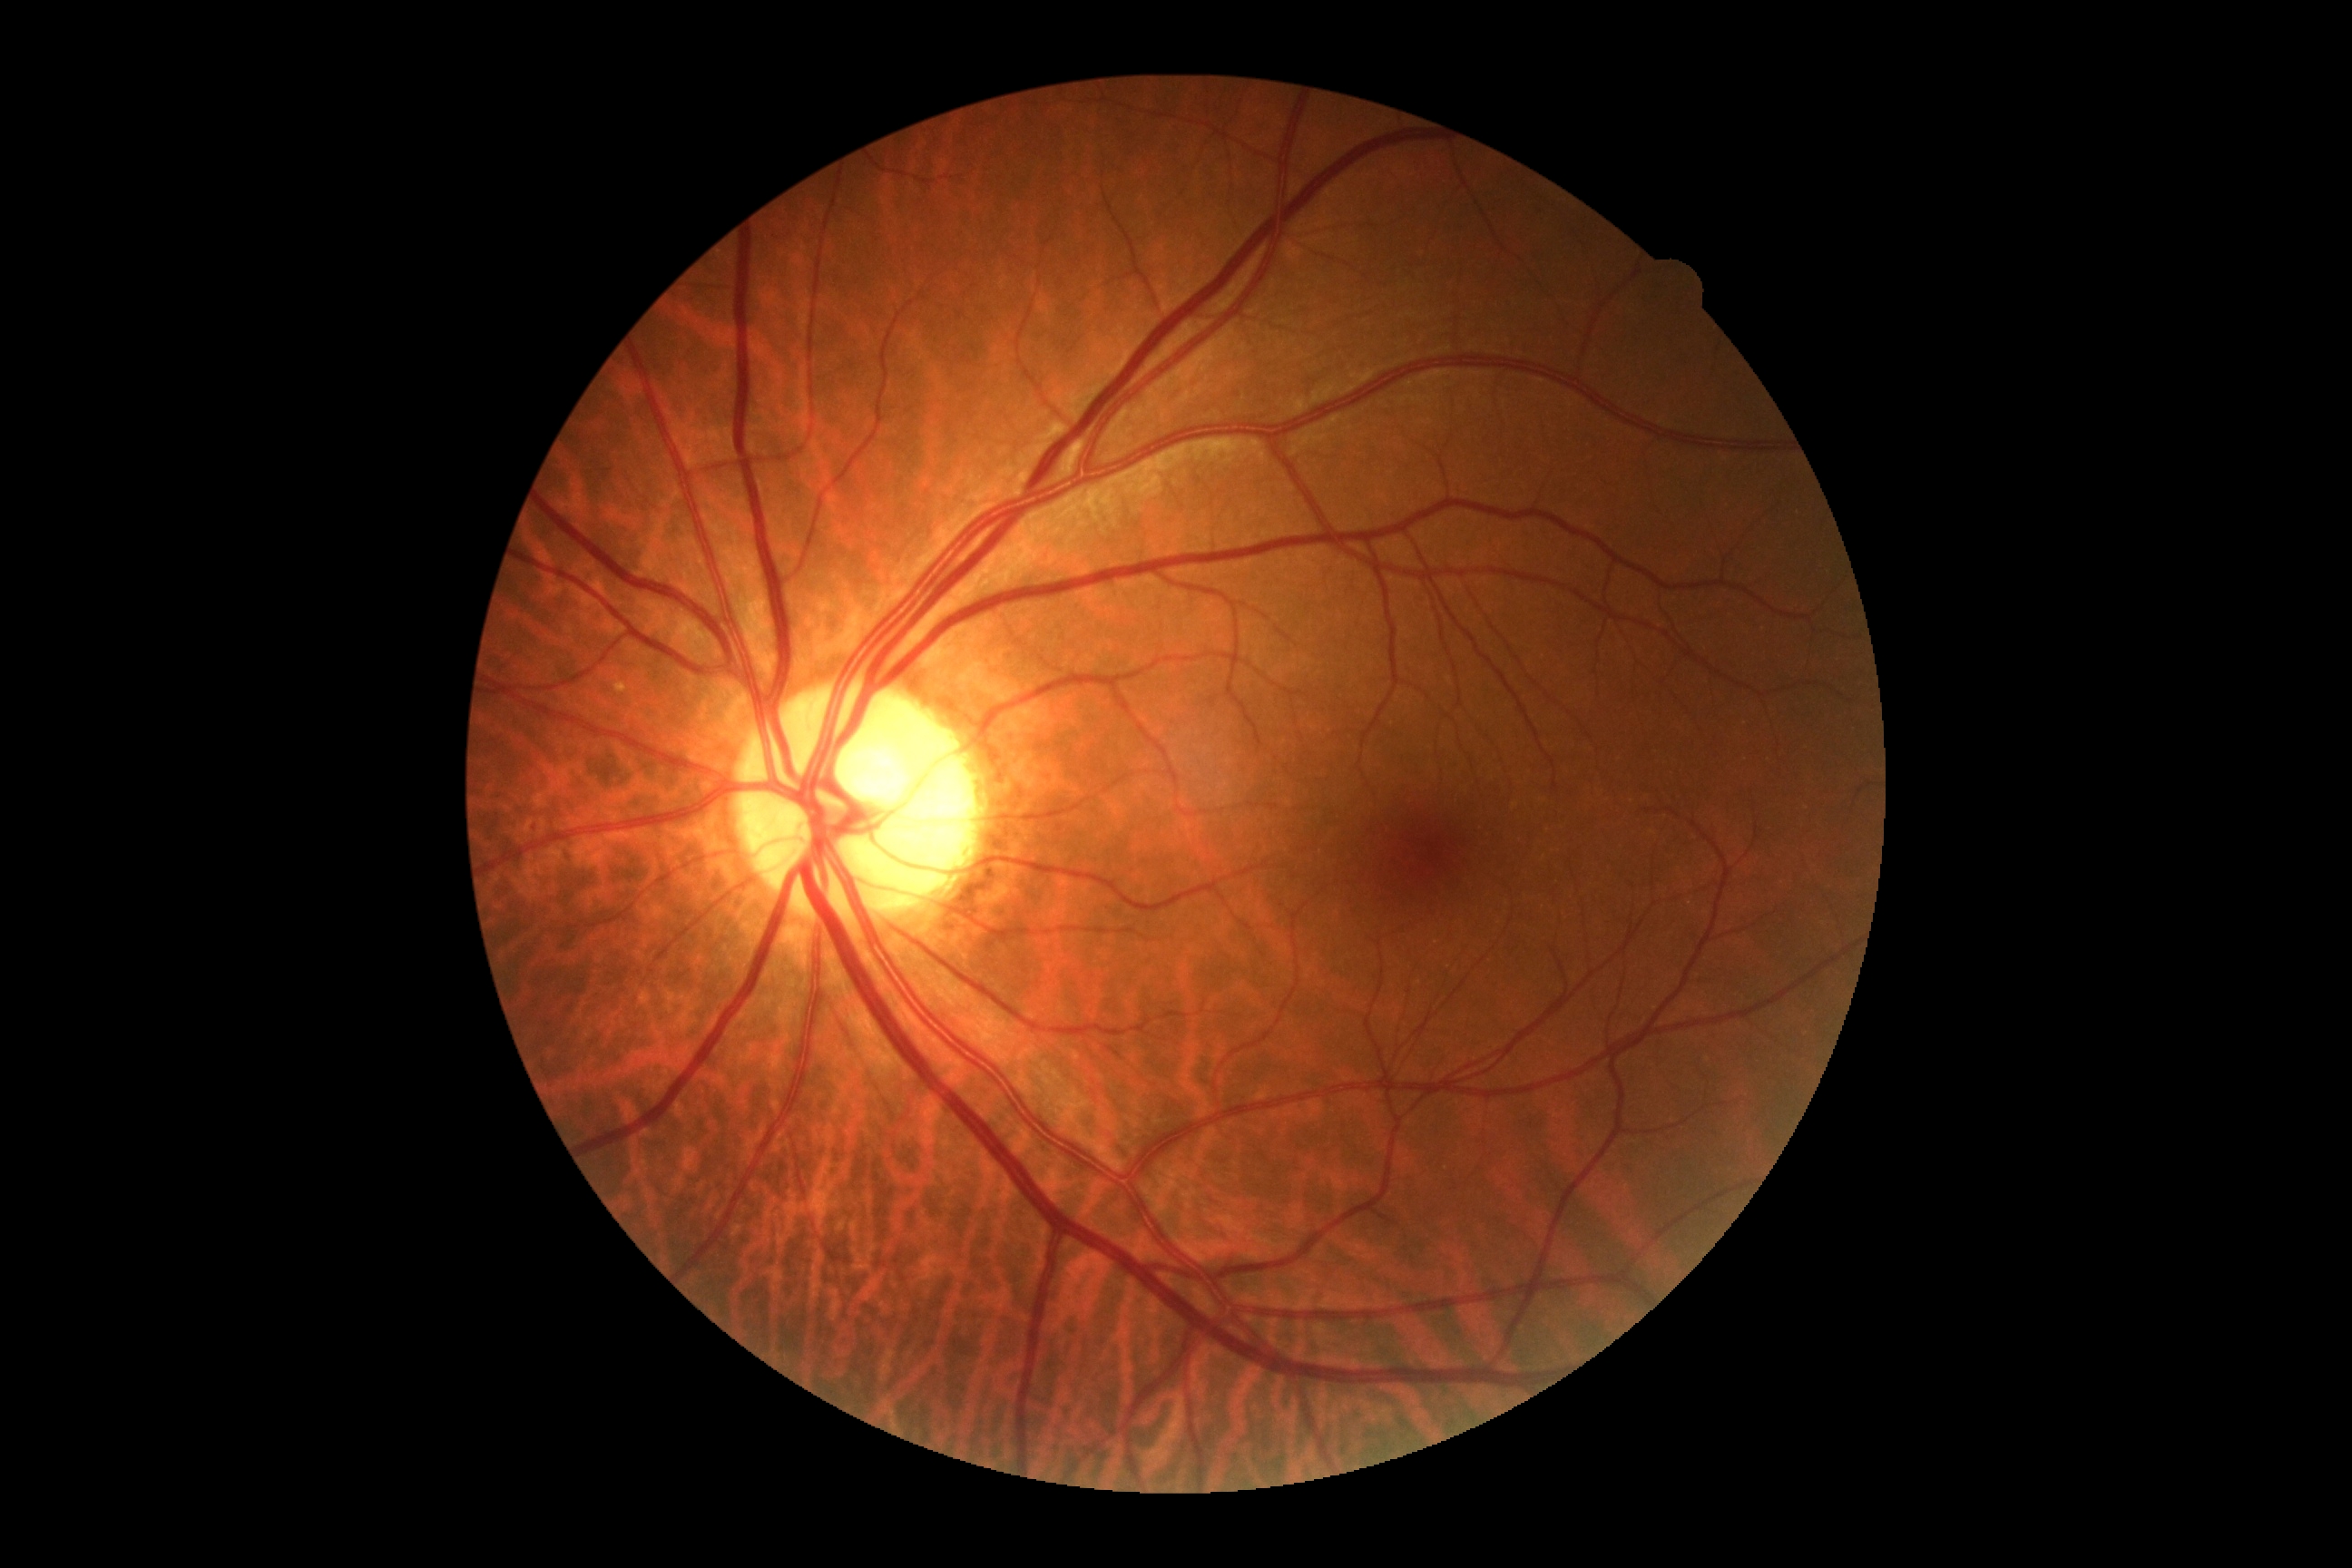 diabetic retinopathy (DR): grade 0 (no apparent retinopathy).